CFP
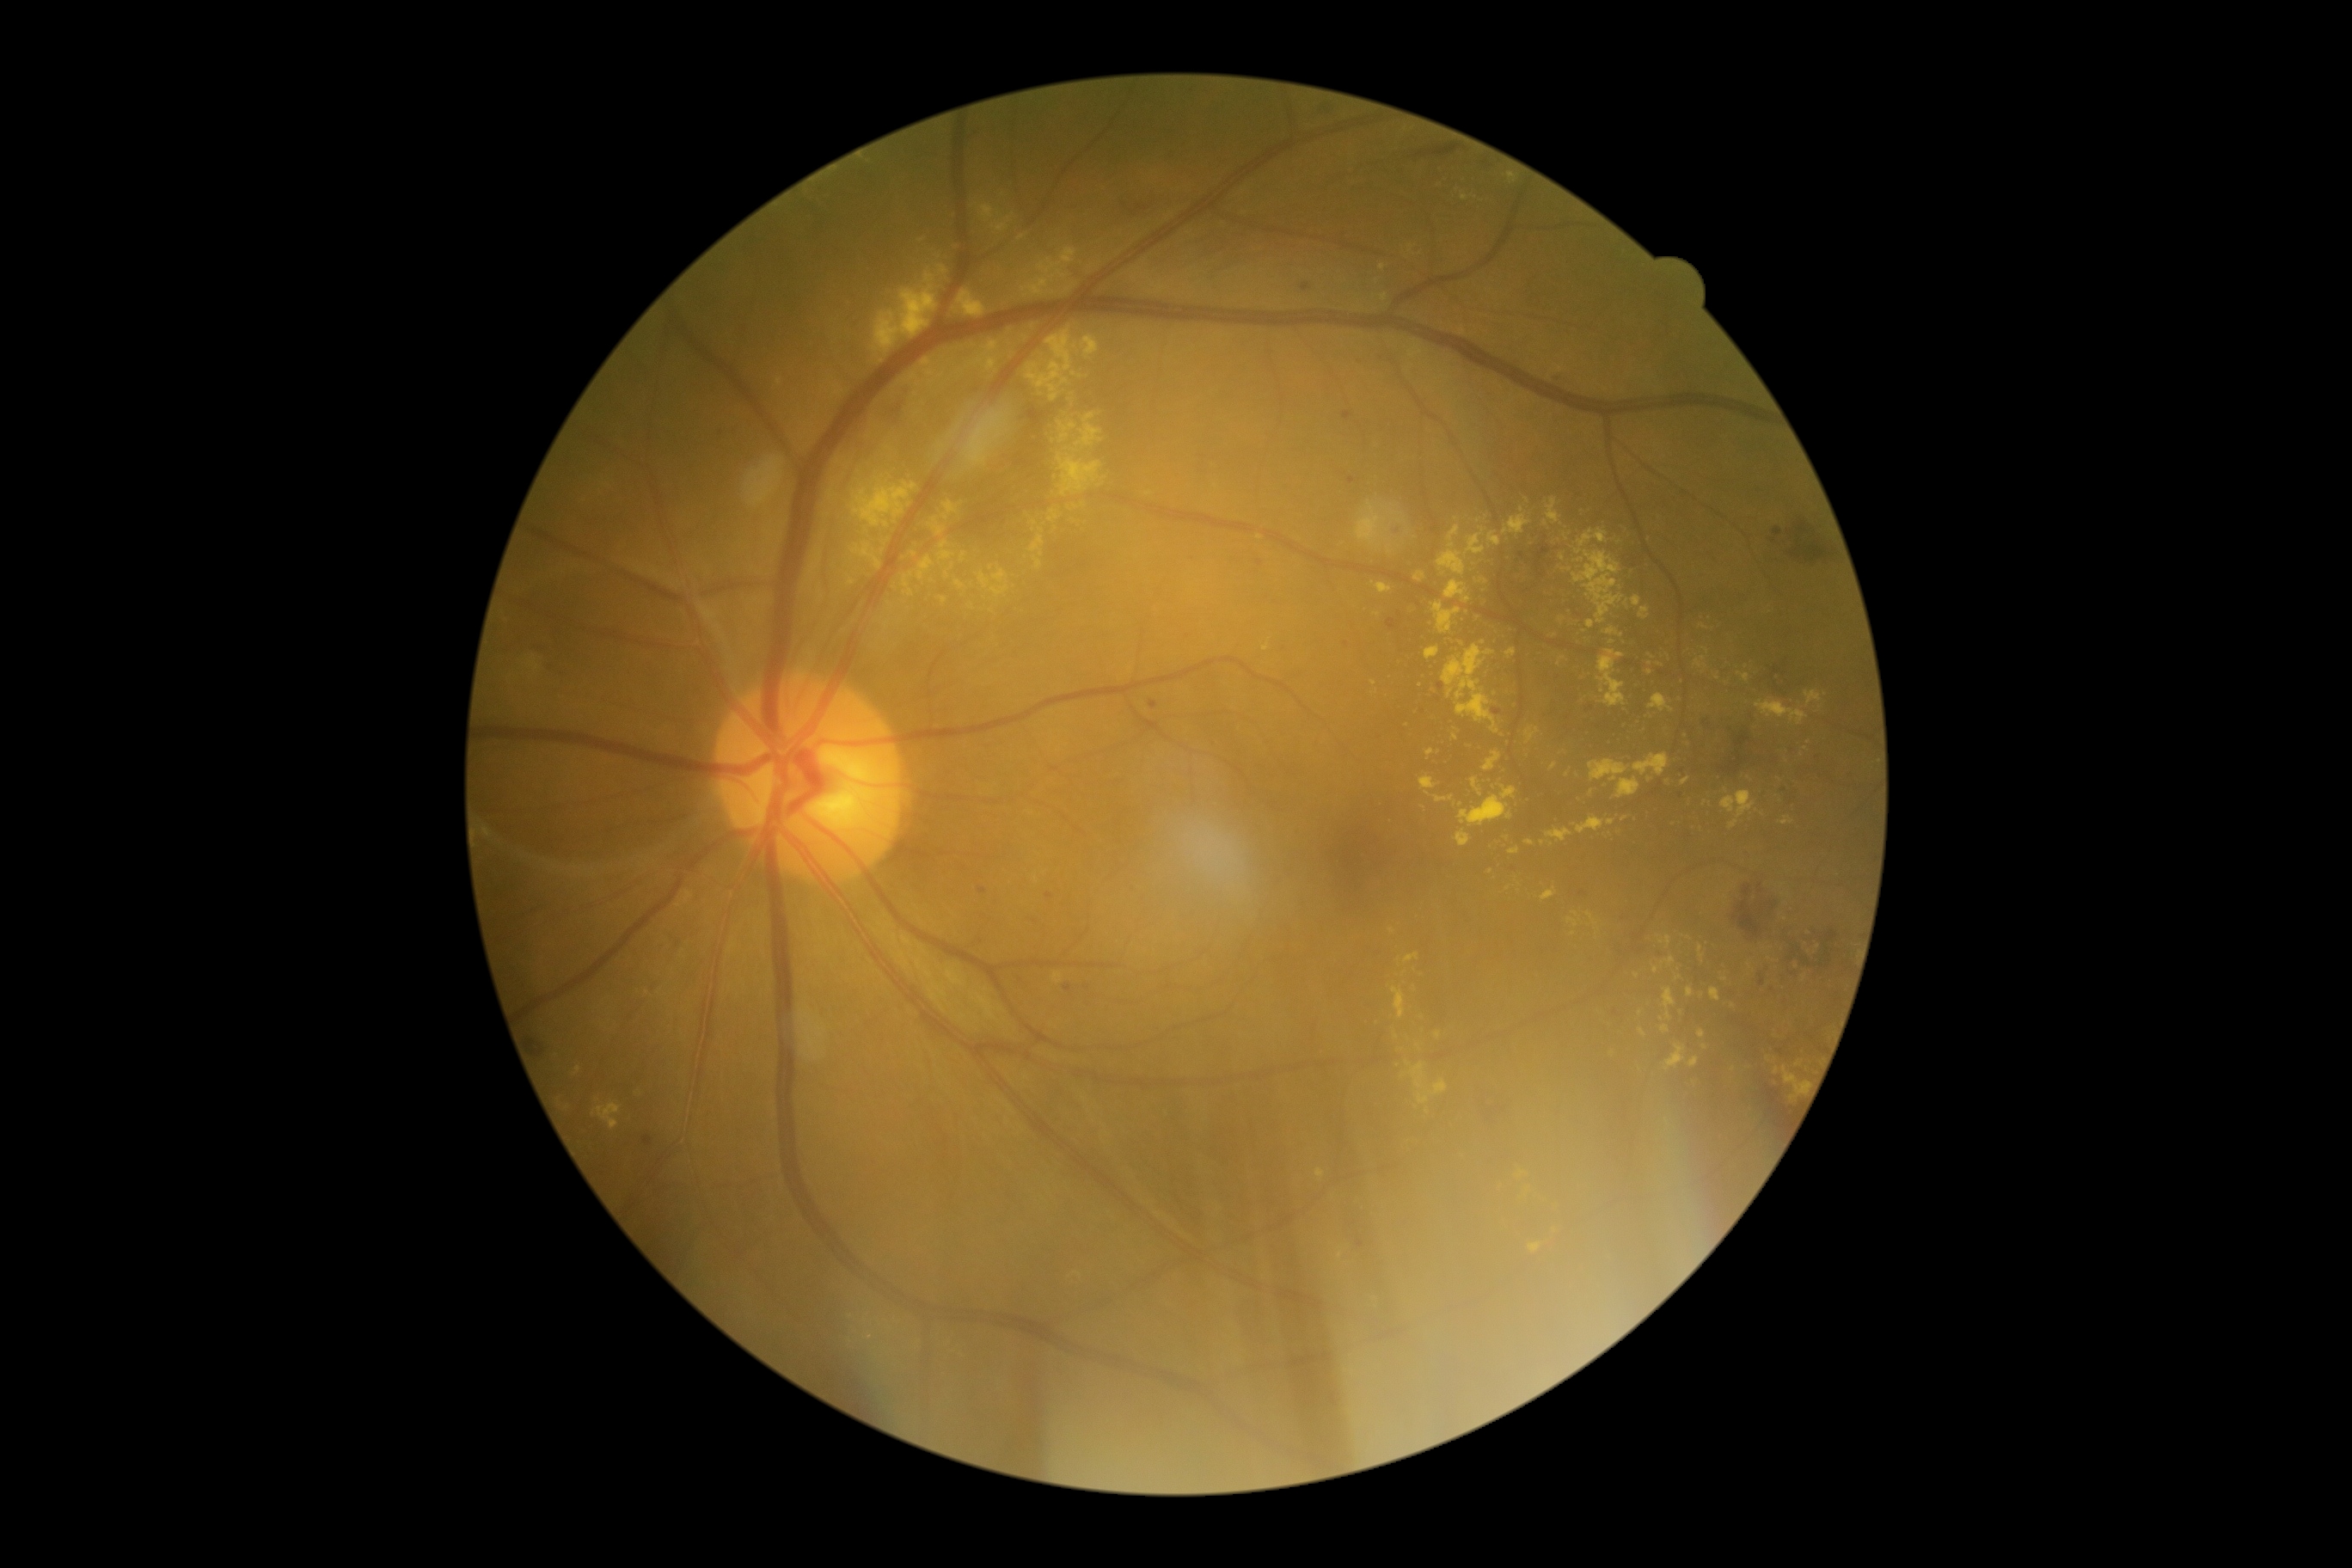
partial: true
dr_grade: 2
lesions:
  ex:
    - x1=955, y1=580, x2=965, y2=591
    - x1=1694, y1=658, x2=1708, y2=668
    - x1=1687, y1=986, x2=1694, y2=998
    - x1=1784, y1=1067, x2=1808, y2=1103
    - x1=1029, y1=536, x2=1046, y2=558
    - x1=1541, y1=888, x2=1559, y2=900
    - x1=1459, y1=795, x2=1514, y2=826
    - x1=1504, y1=515, x2=1531, y2=536
    - x1=575, y1=1067, x2=582, y2=1075
    - x1=1806, y1=690, x2=1822, y2=706
  ex_small:
    - [1385,508]
    - [1777,1071]
    - [1393,931]
    - [1483,643]
    - [1574,932]
    - [1456,737]
    - [1667,1121]
    - [947,575]
    - [1804,977]